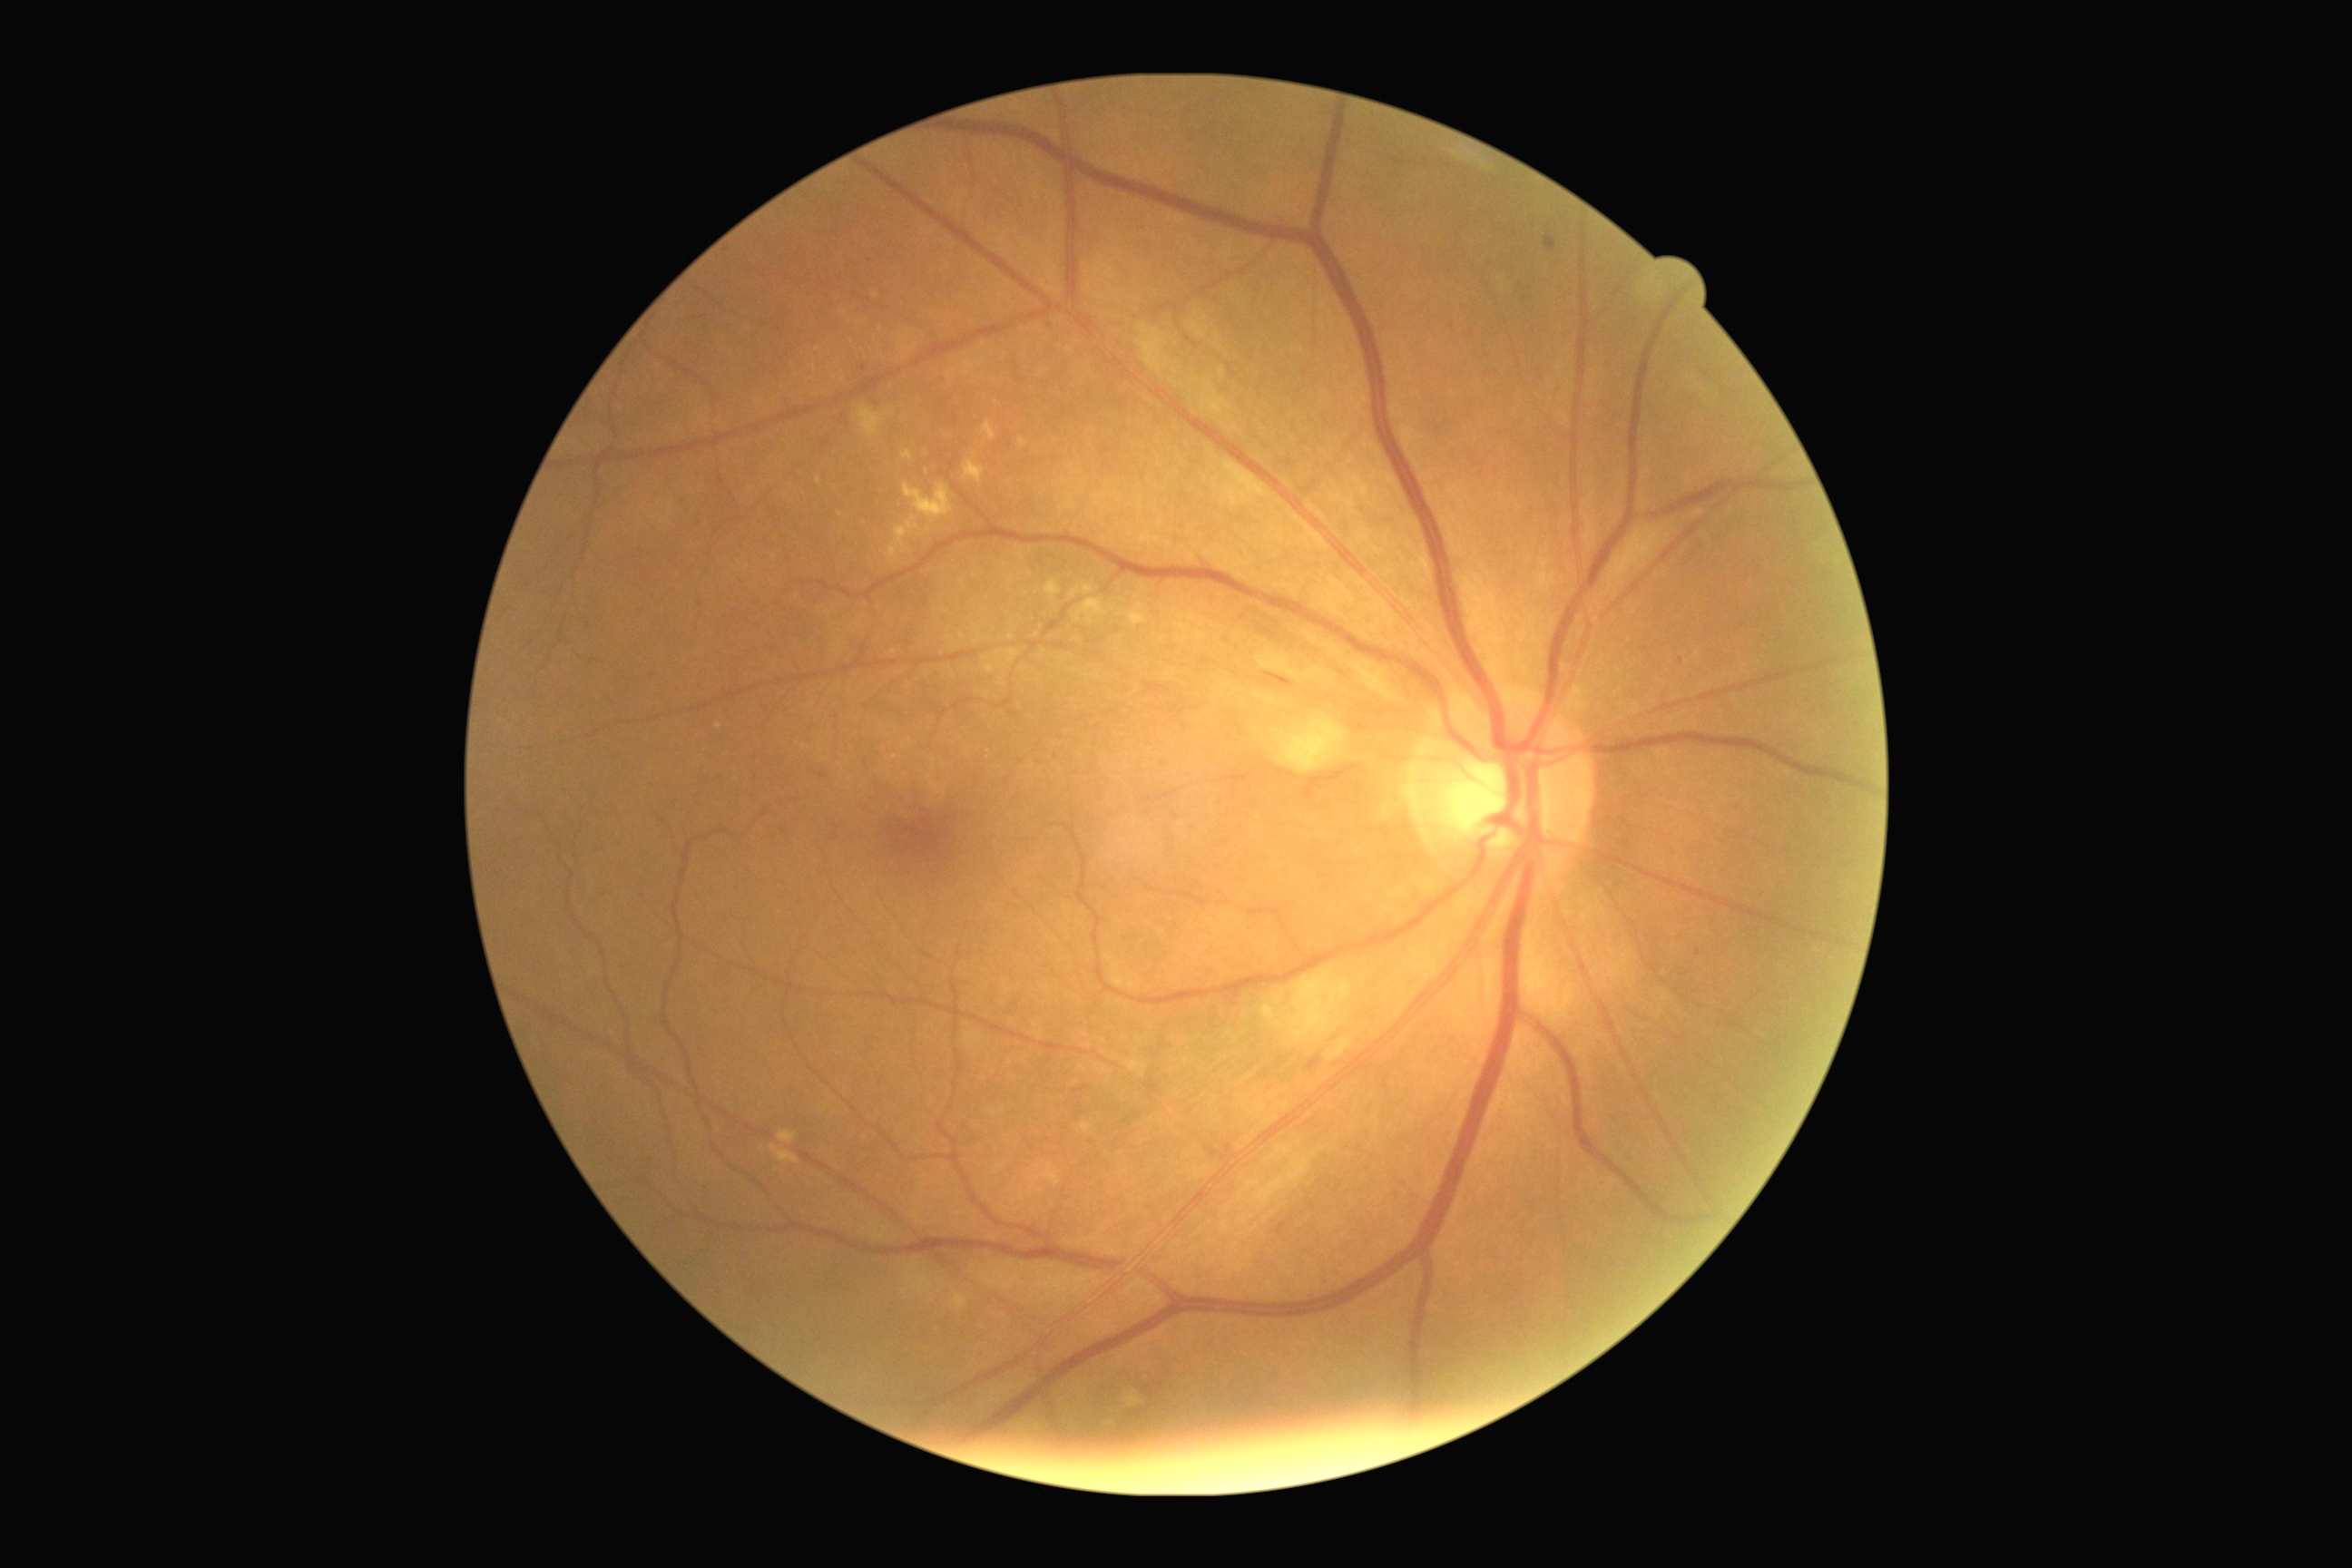
DR is 2/4.